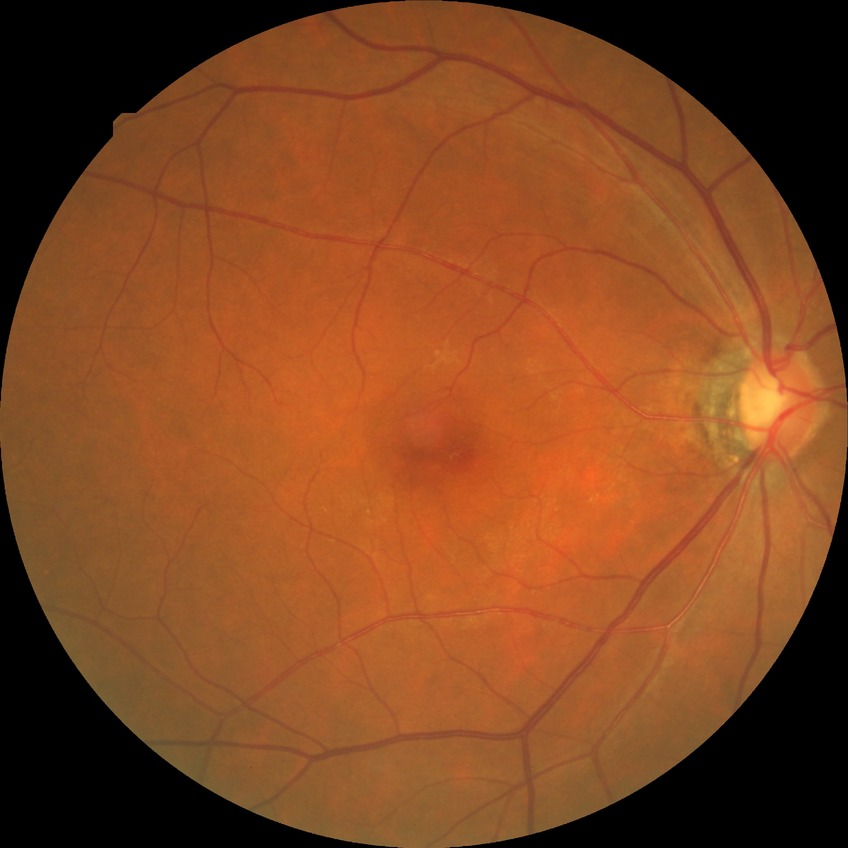

{"davis_grade": "no diabetic retinopathy"}